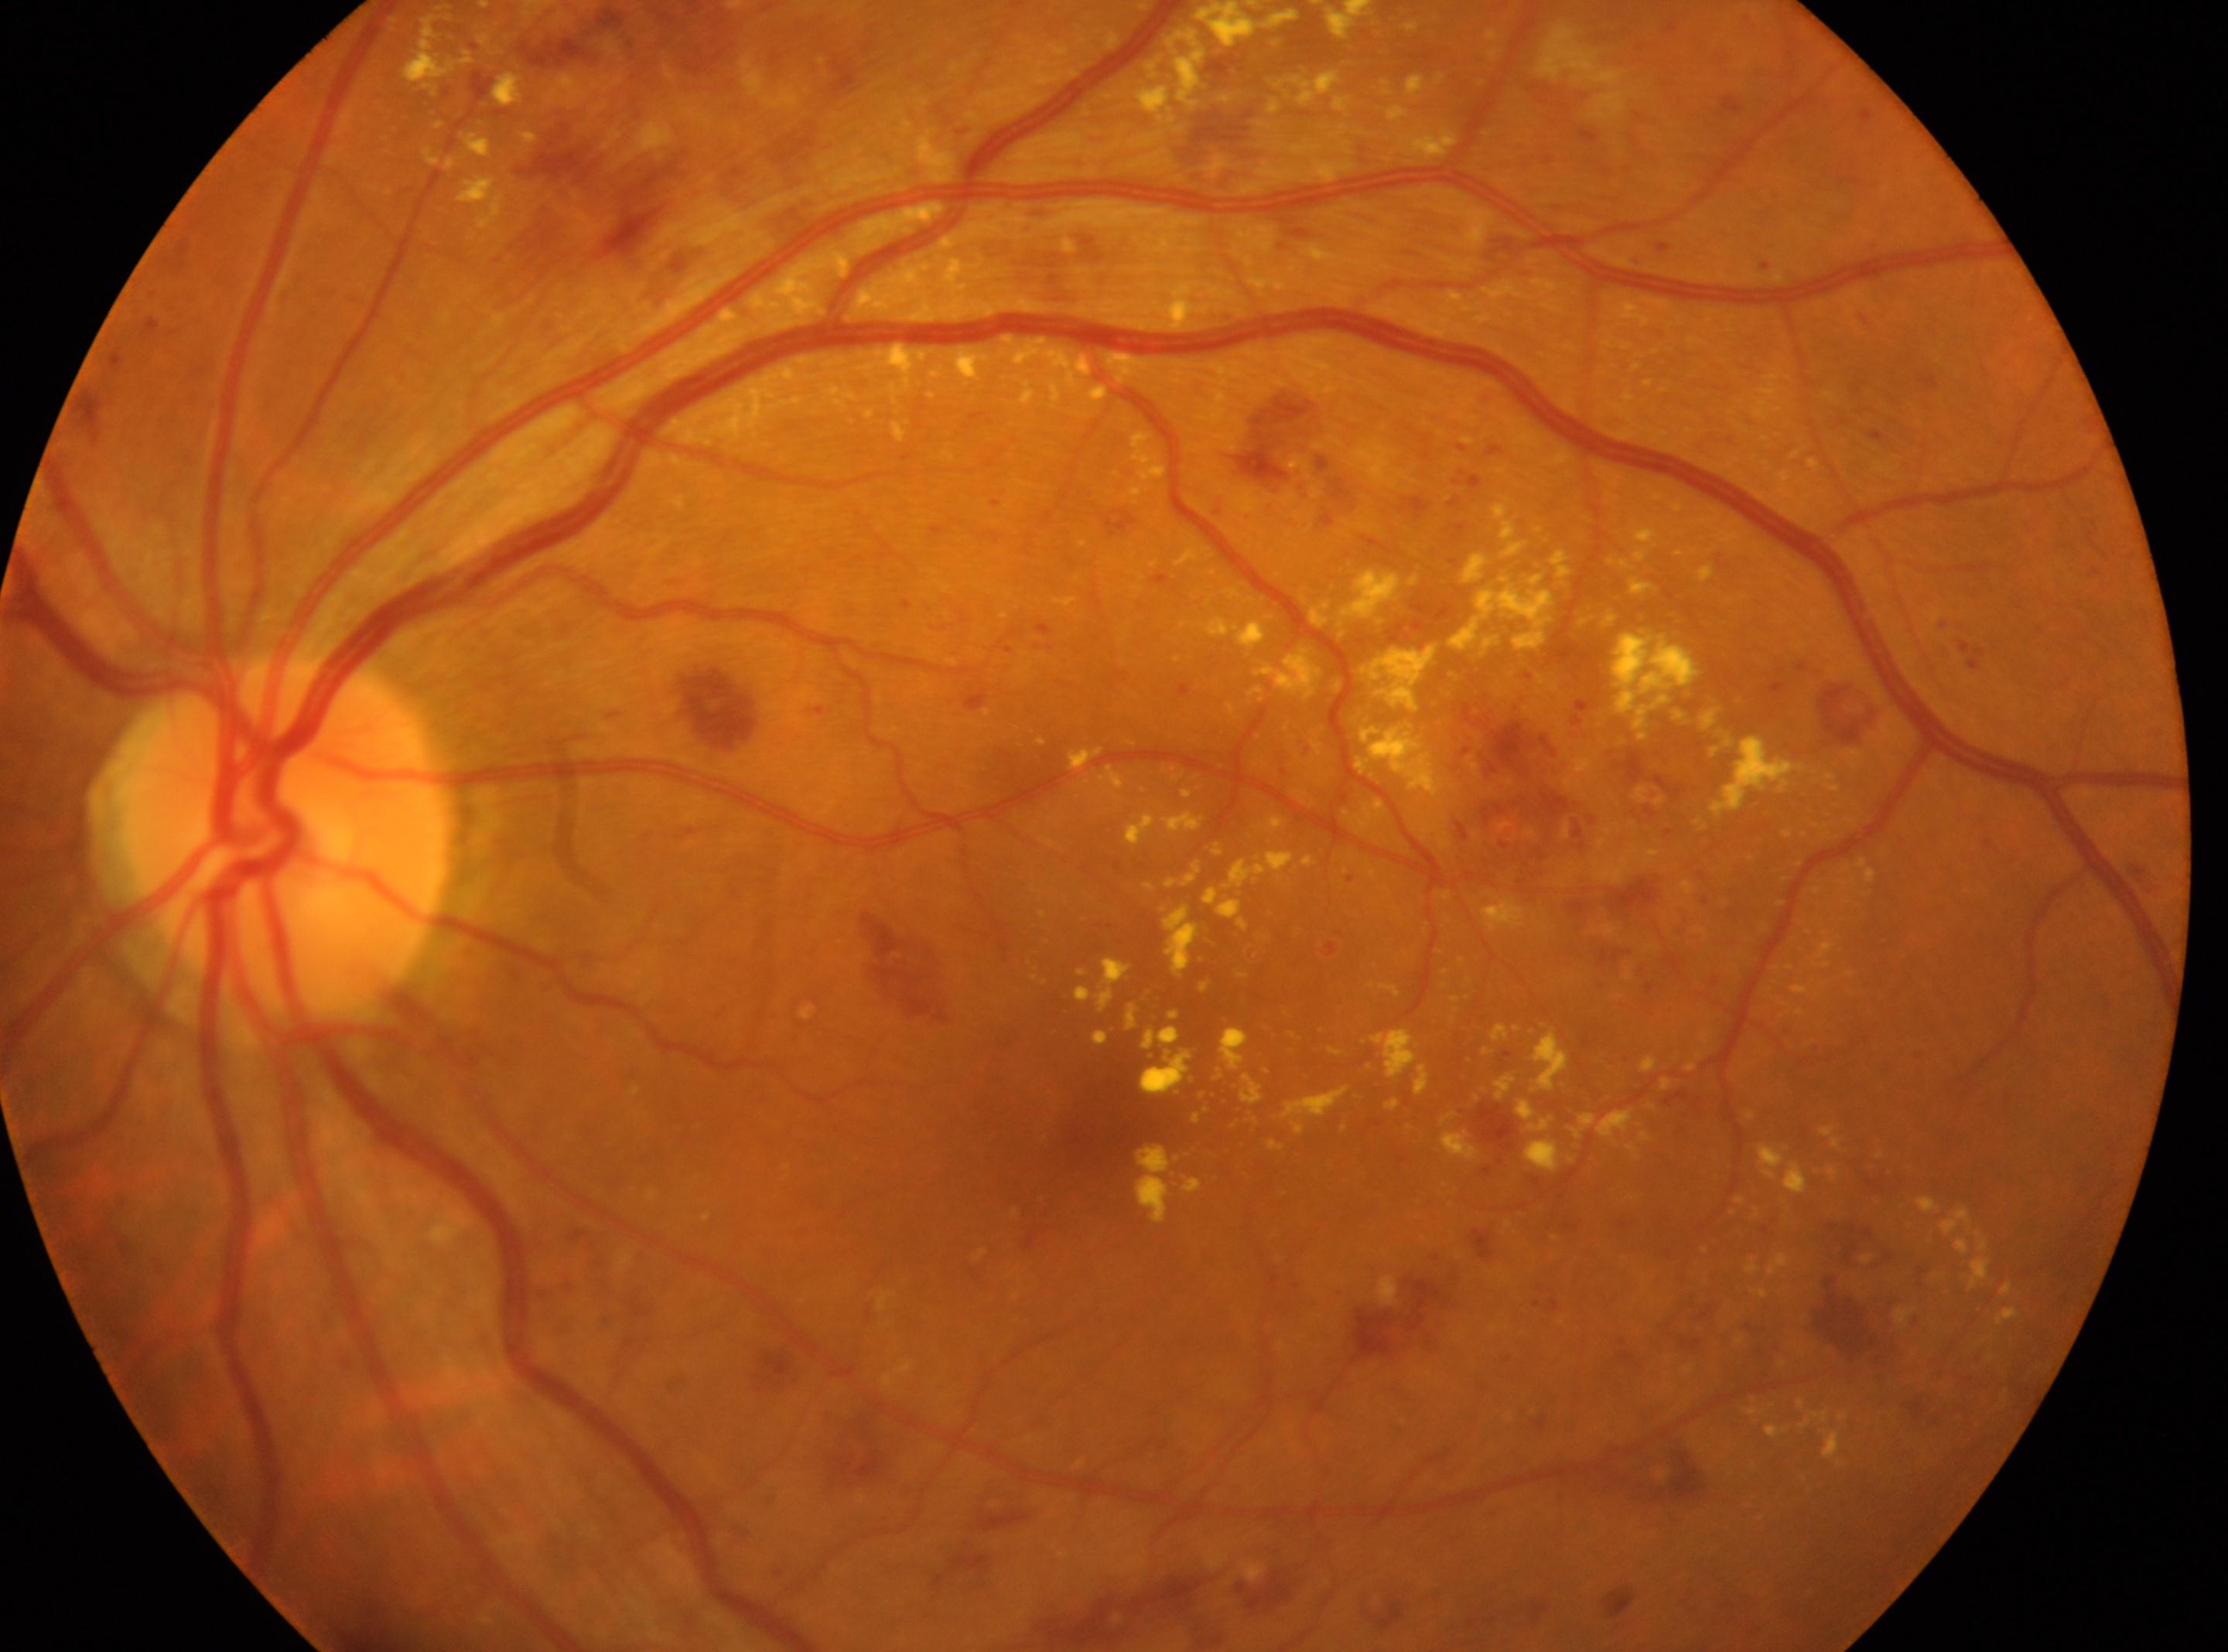

| key | value |
|---|---|
| fovea centralis | (x=1094, y=1117) |
| retinopathy | severe non-proliferative diabetic retinopathy (grade 3) — more than 20 intraretinal hemorrhages in each of 4 quadrants, definite venous beading in 2 or more quadrants, or prominent intraretinal microvascular abnormalities in 1 or more quadrants, with no signs of proliferative retinopathy |
| optic nerve head | (x=285, y=838) |
| laterality | left |